Image size 1923x1932, color fundus photograph, 45° field of view: 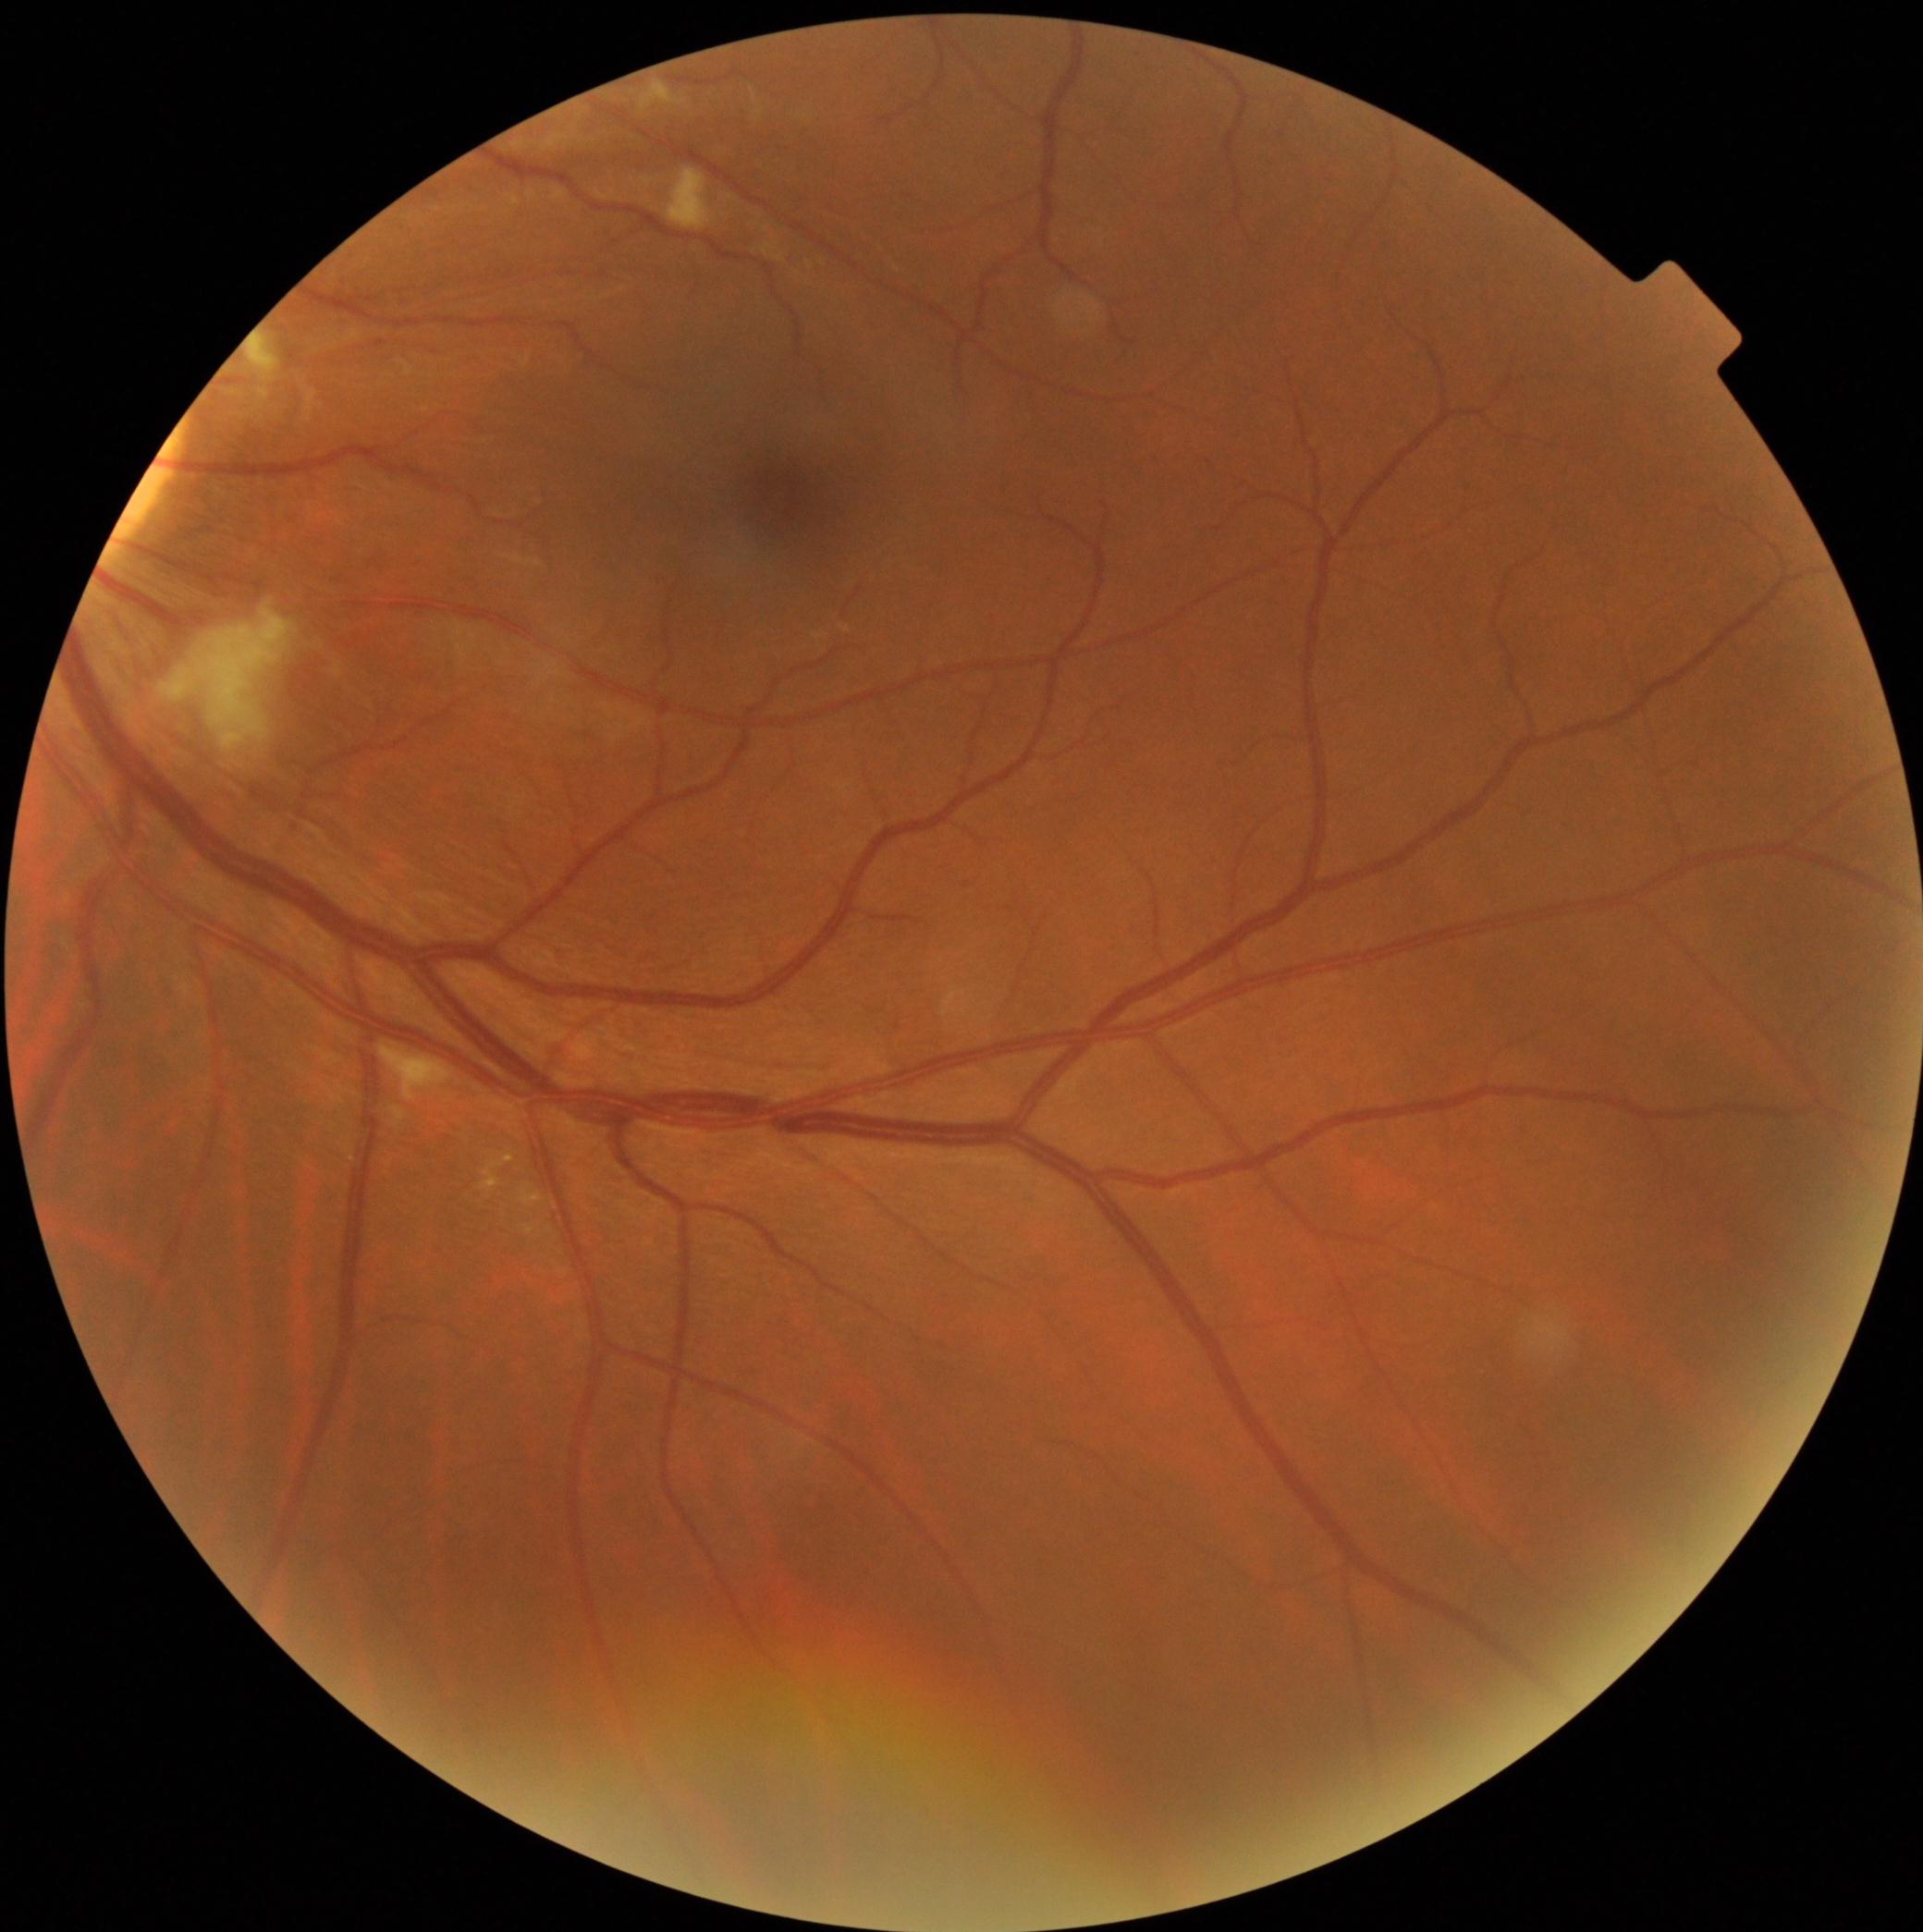

DR stage = grade 2.